Acquired with a Topcon TRC, fundus photograph cropped around the optic nerve head: 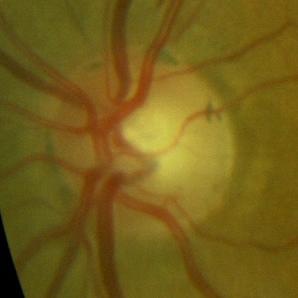

Consistent with no glaucomatous optic neuropathy.